Image size 1659x2212 — 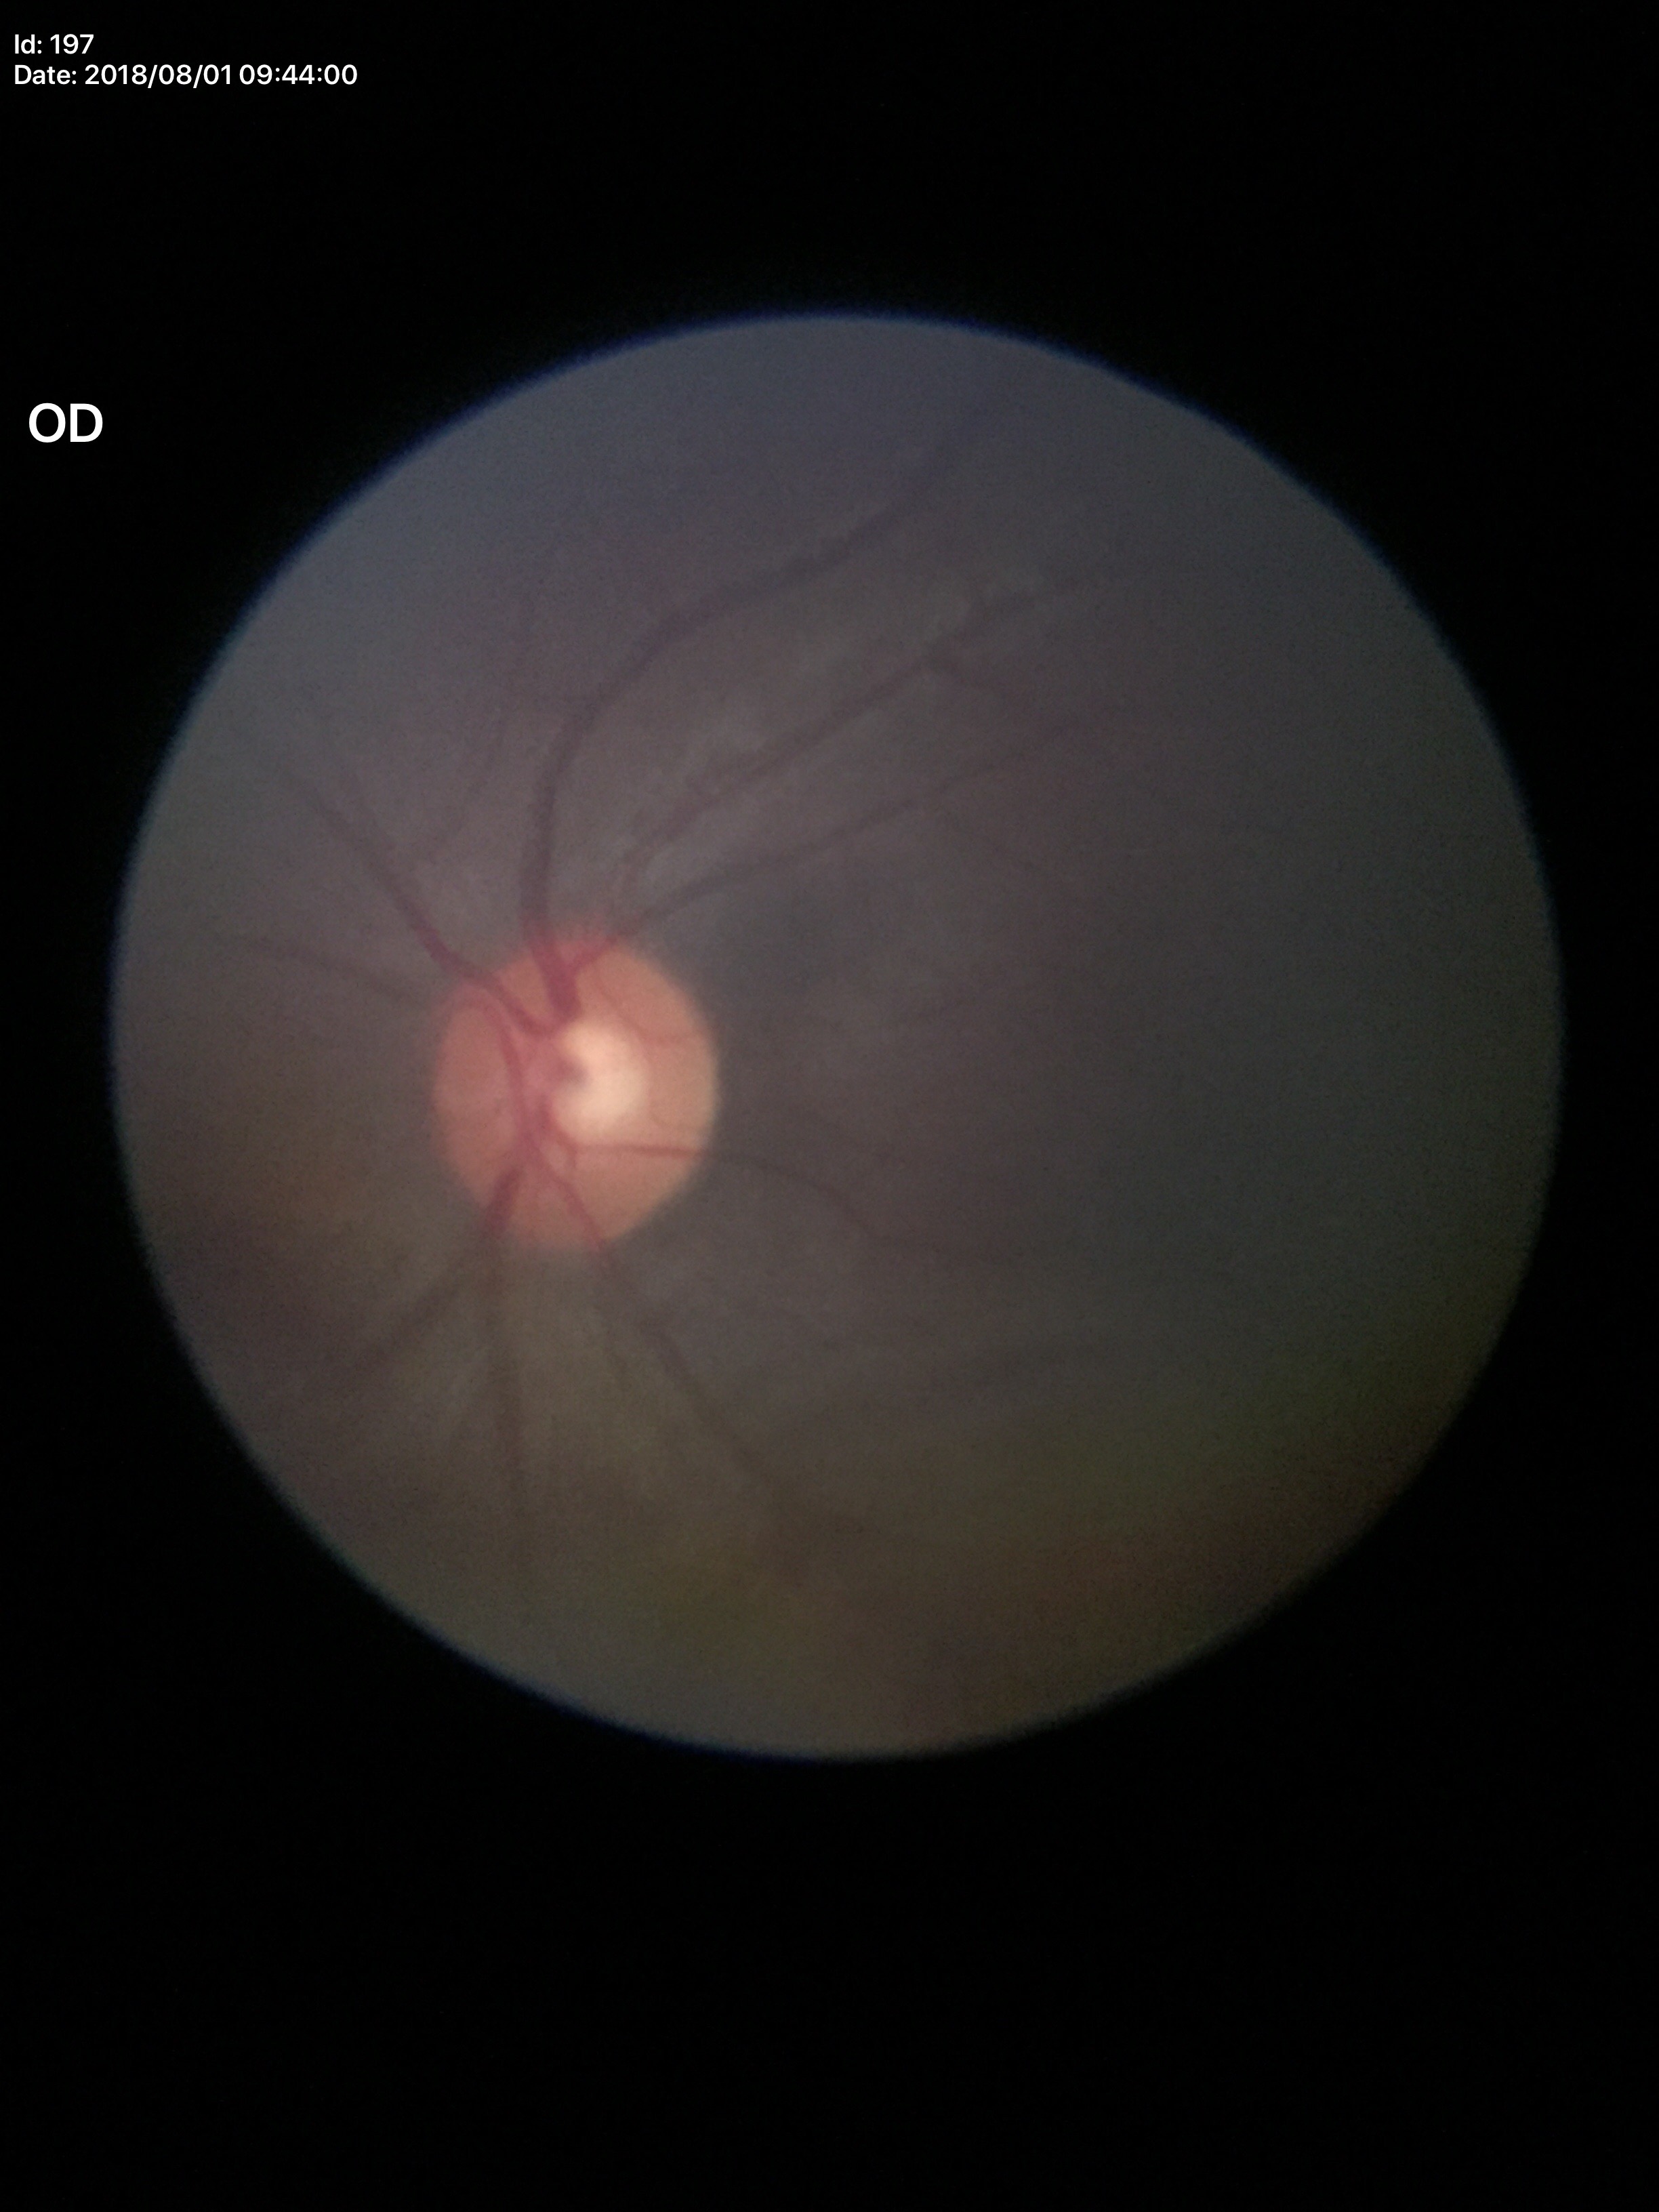
Vertical cup-to-disc ratio (VCDR) of 0.48.
Glaucoma screening: no suspicious findings.
Horizontal cup-disc ratio (HCDR) is 0.48.